Remidio smartphone fundus camera:
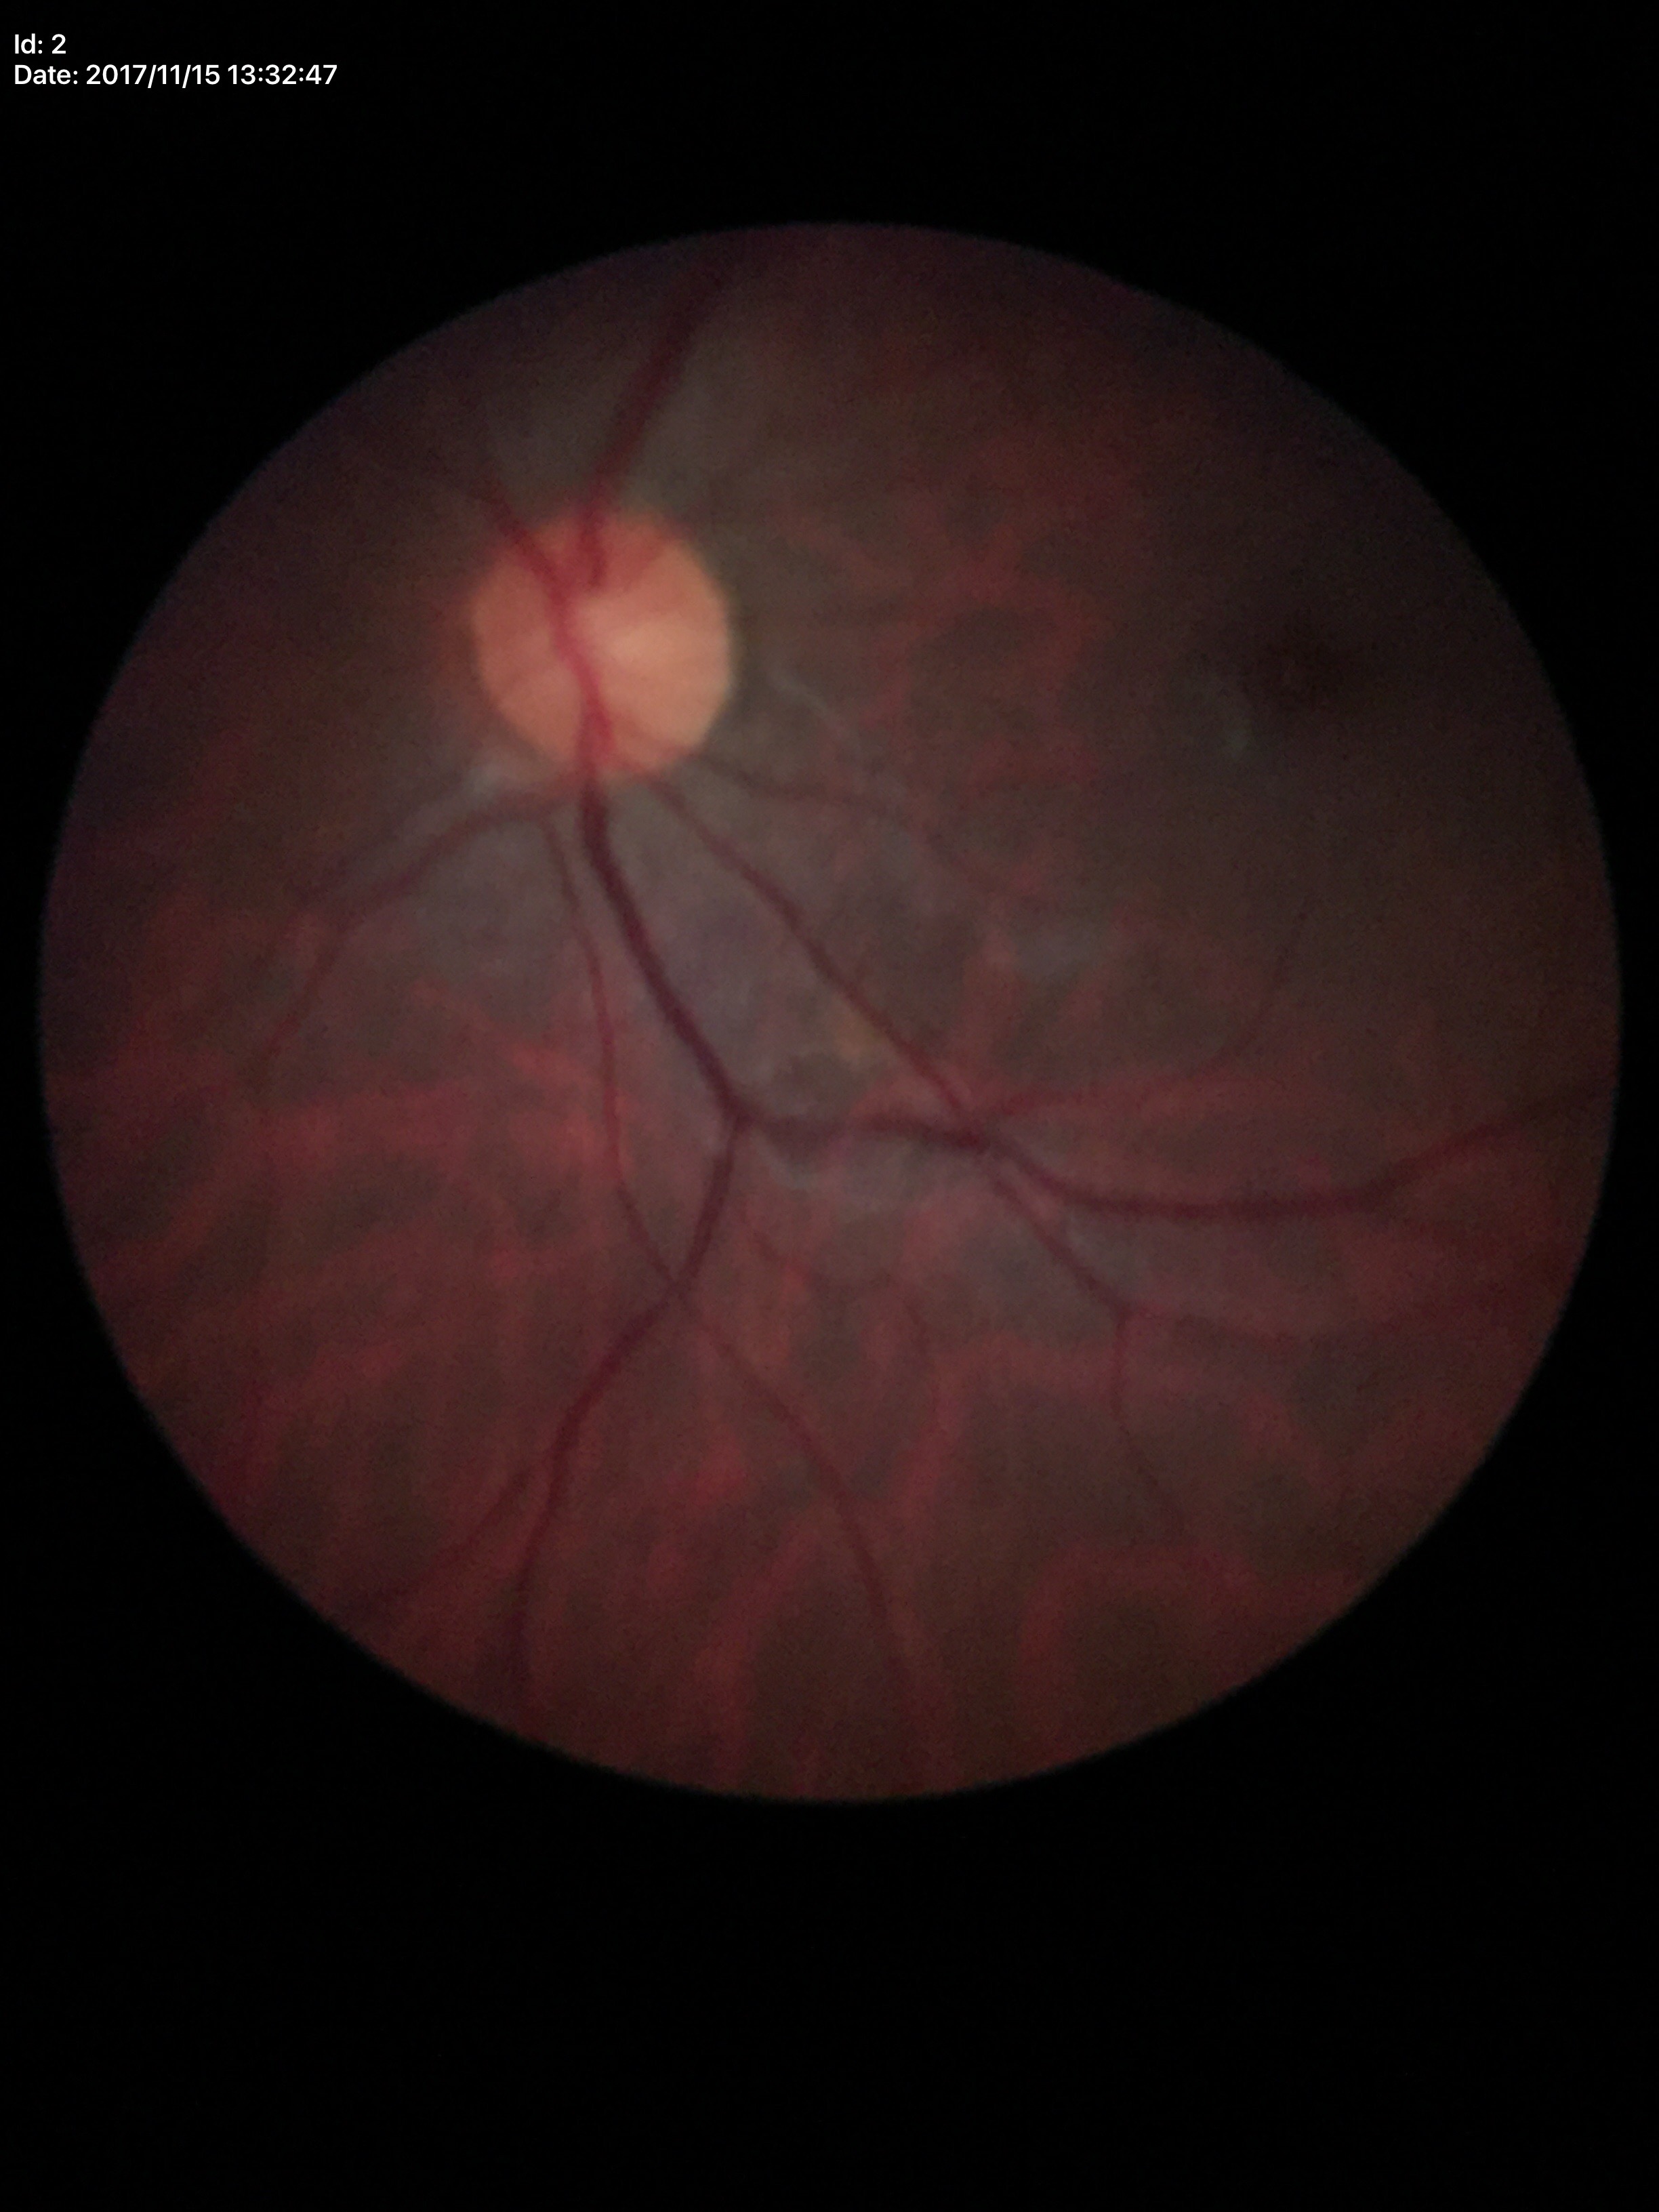

Vertical cup-to-disc ratio of 0.49.
Glaucoma screening impression: no suspicious findings (unanimous normal call).